Graded on the modified Davis scale — 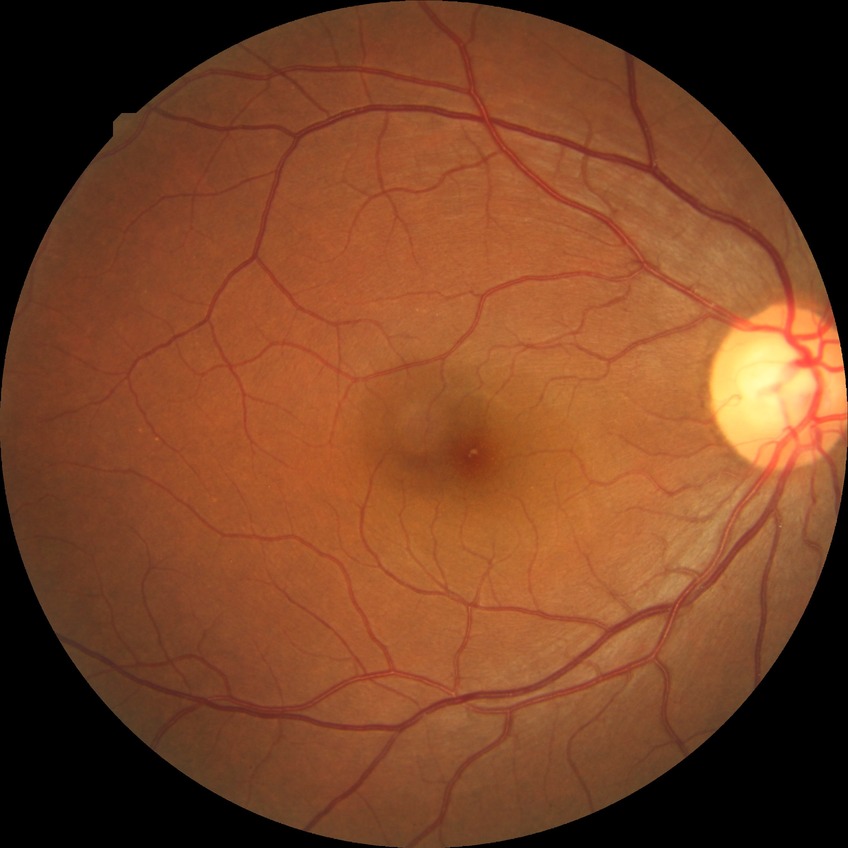 diabetic retinopathy (DR): NDR (no diabetic retinopathy)